848 x 848 pixels — 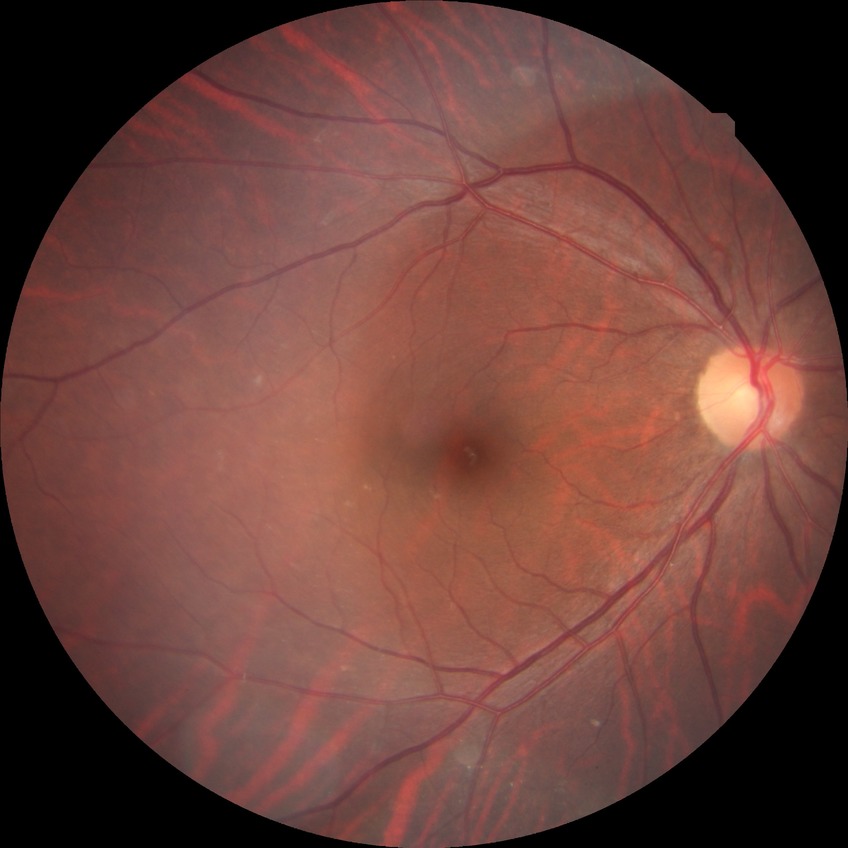 Diabetic retinopathy (DR) is NDR (no diabetic retinopathy).